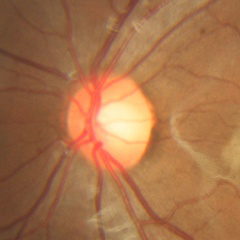 Demonstrates no glaucomatous optic neuropathy.